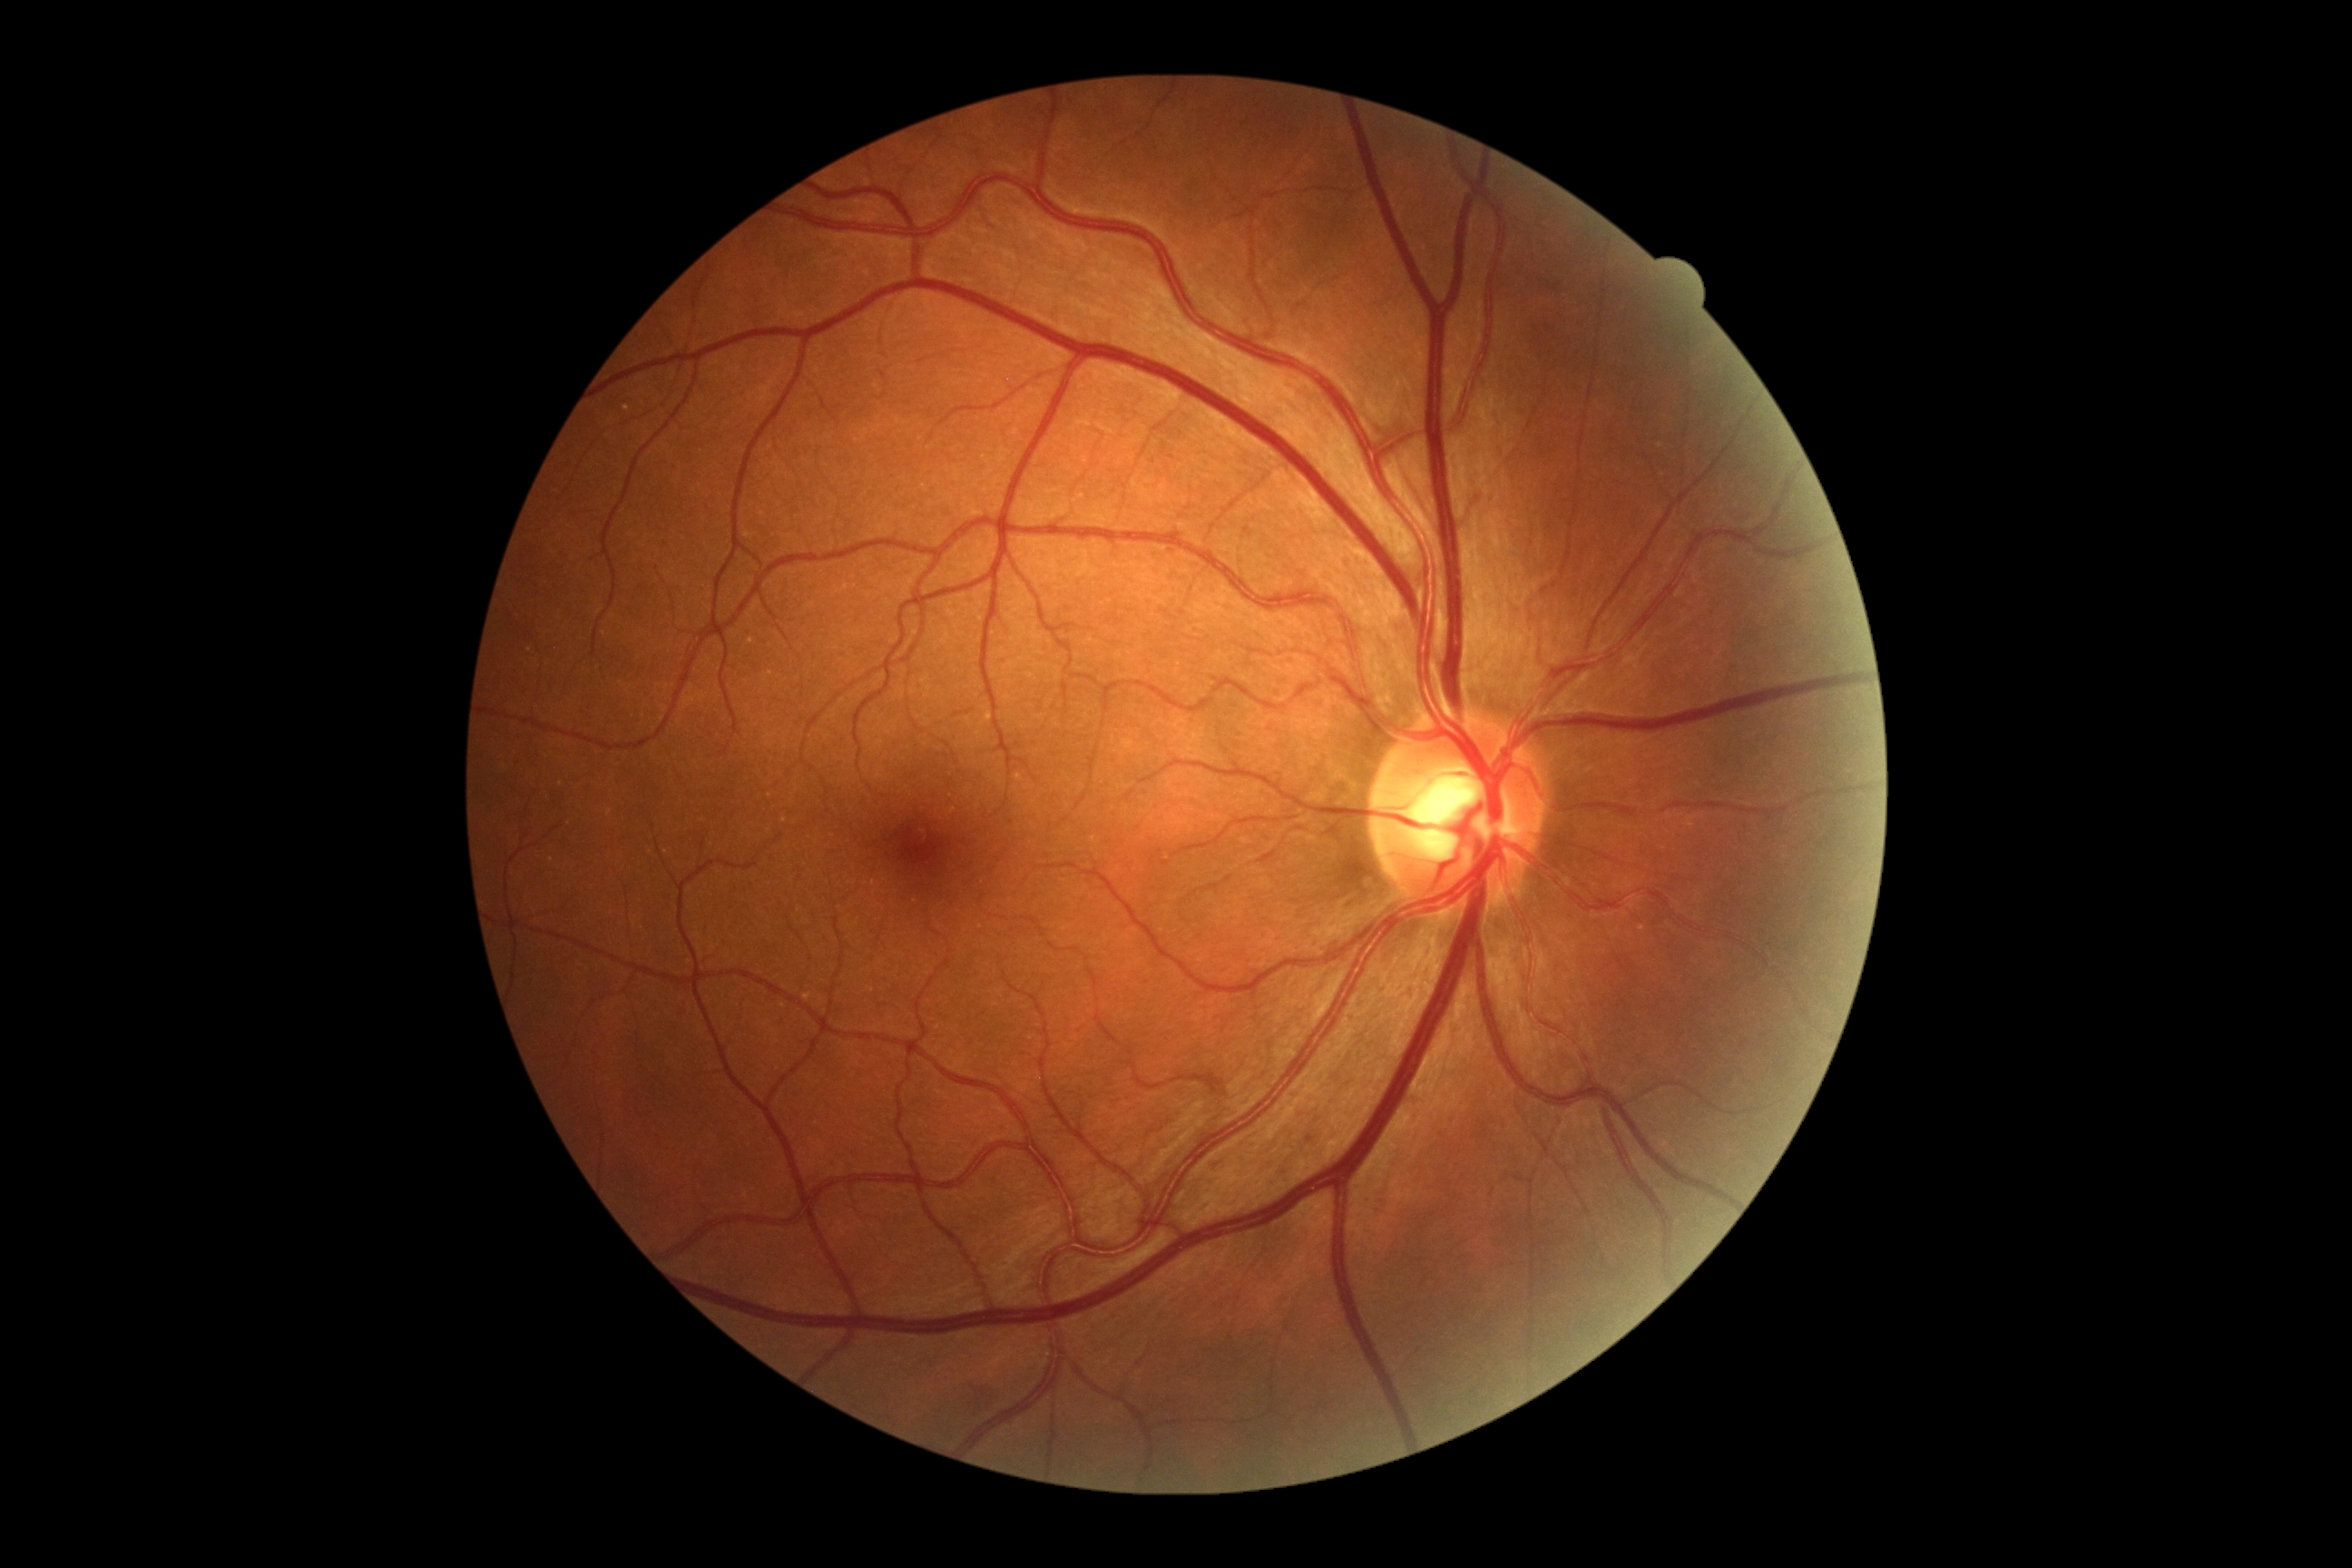
DR: 0.